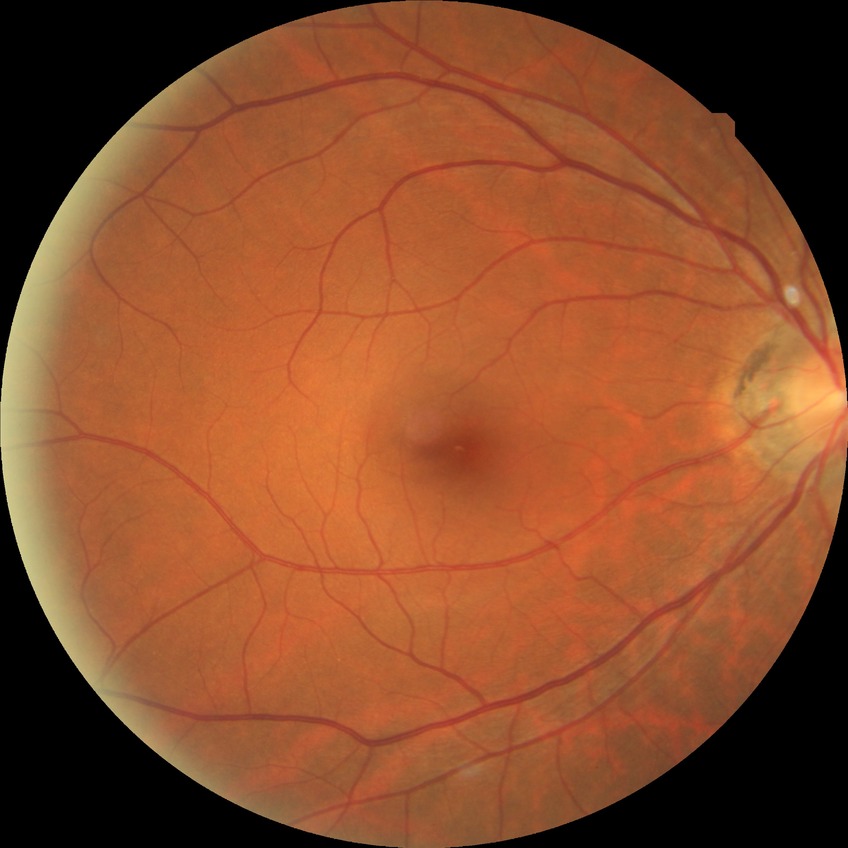
Diabetic retinopathy stage is no diabetic retinopathy.